45° FOV
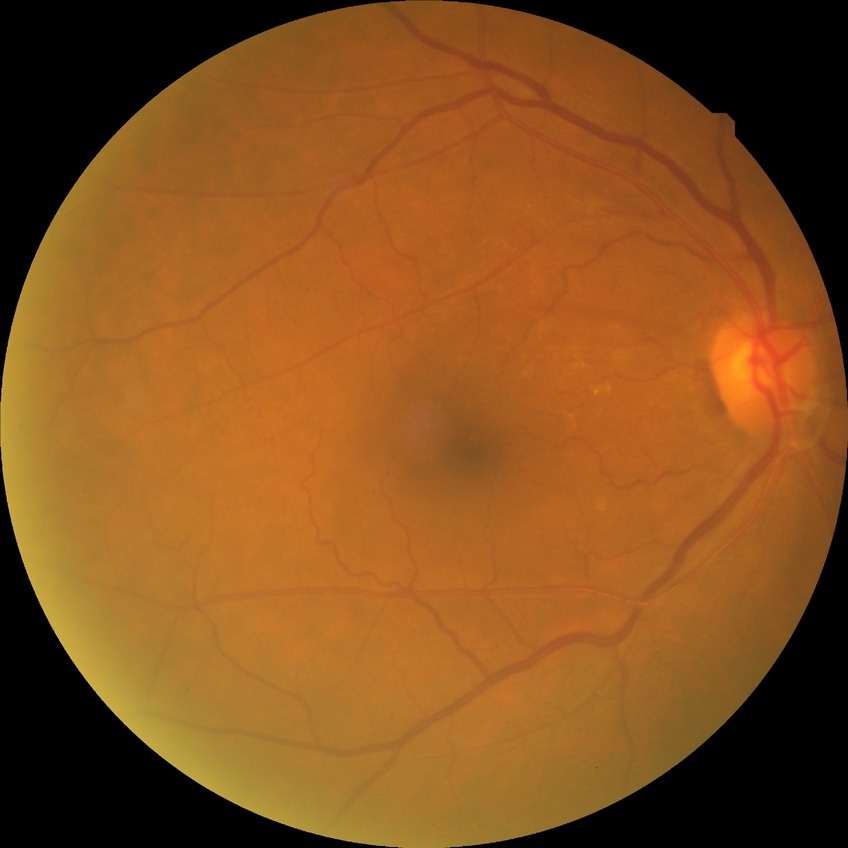 Diabetic retinopathy (DR) is SDR (simple diabetic retinopathy).